Wide-field fundus photograph from neonatal ROP screening:
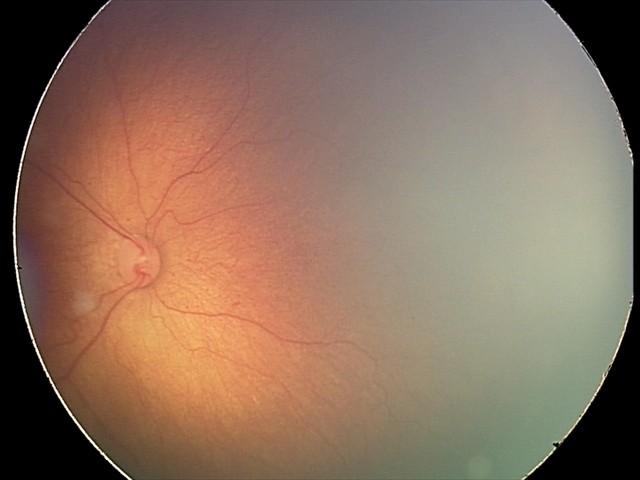 Assessment: retinopathy of prematurity (ROP) stage 2.